Color fundus image · 45-degree field of view: 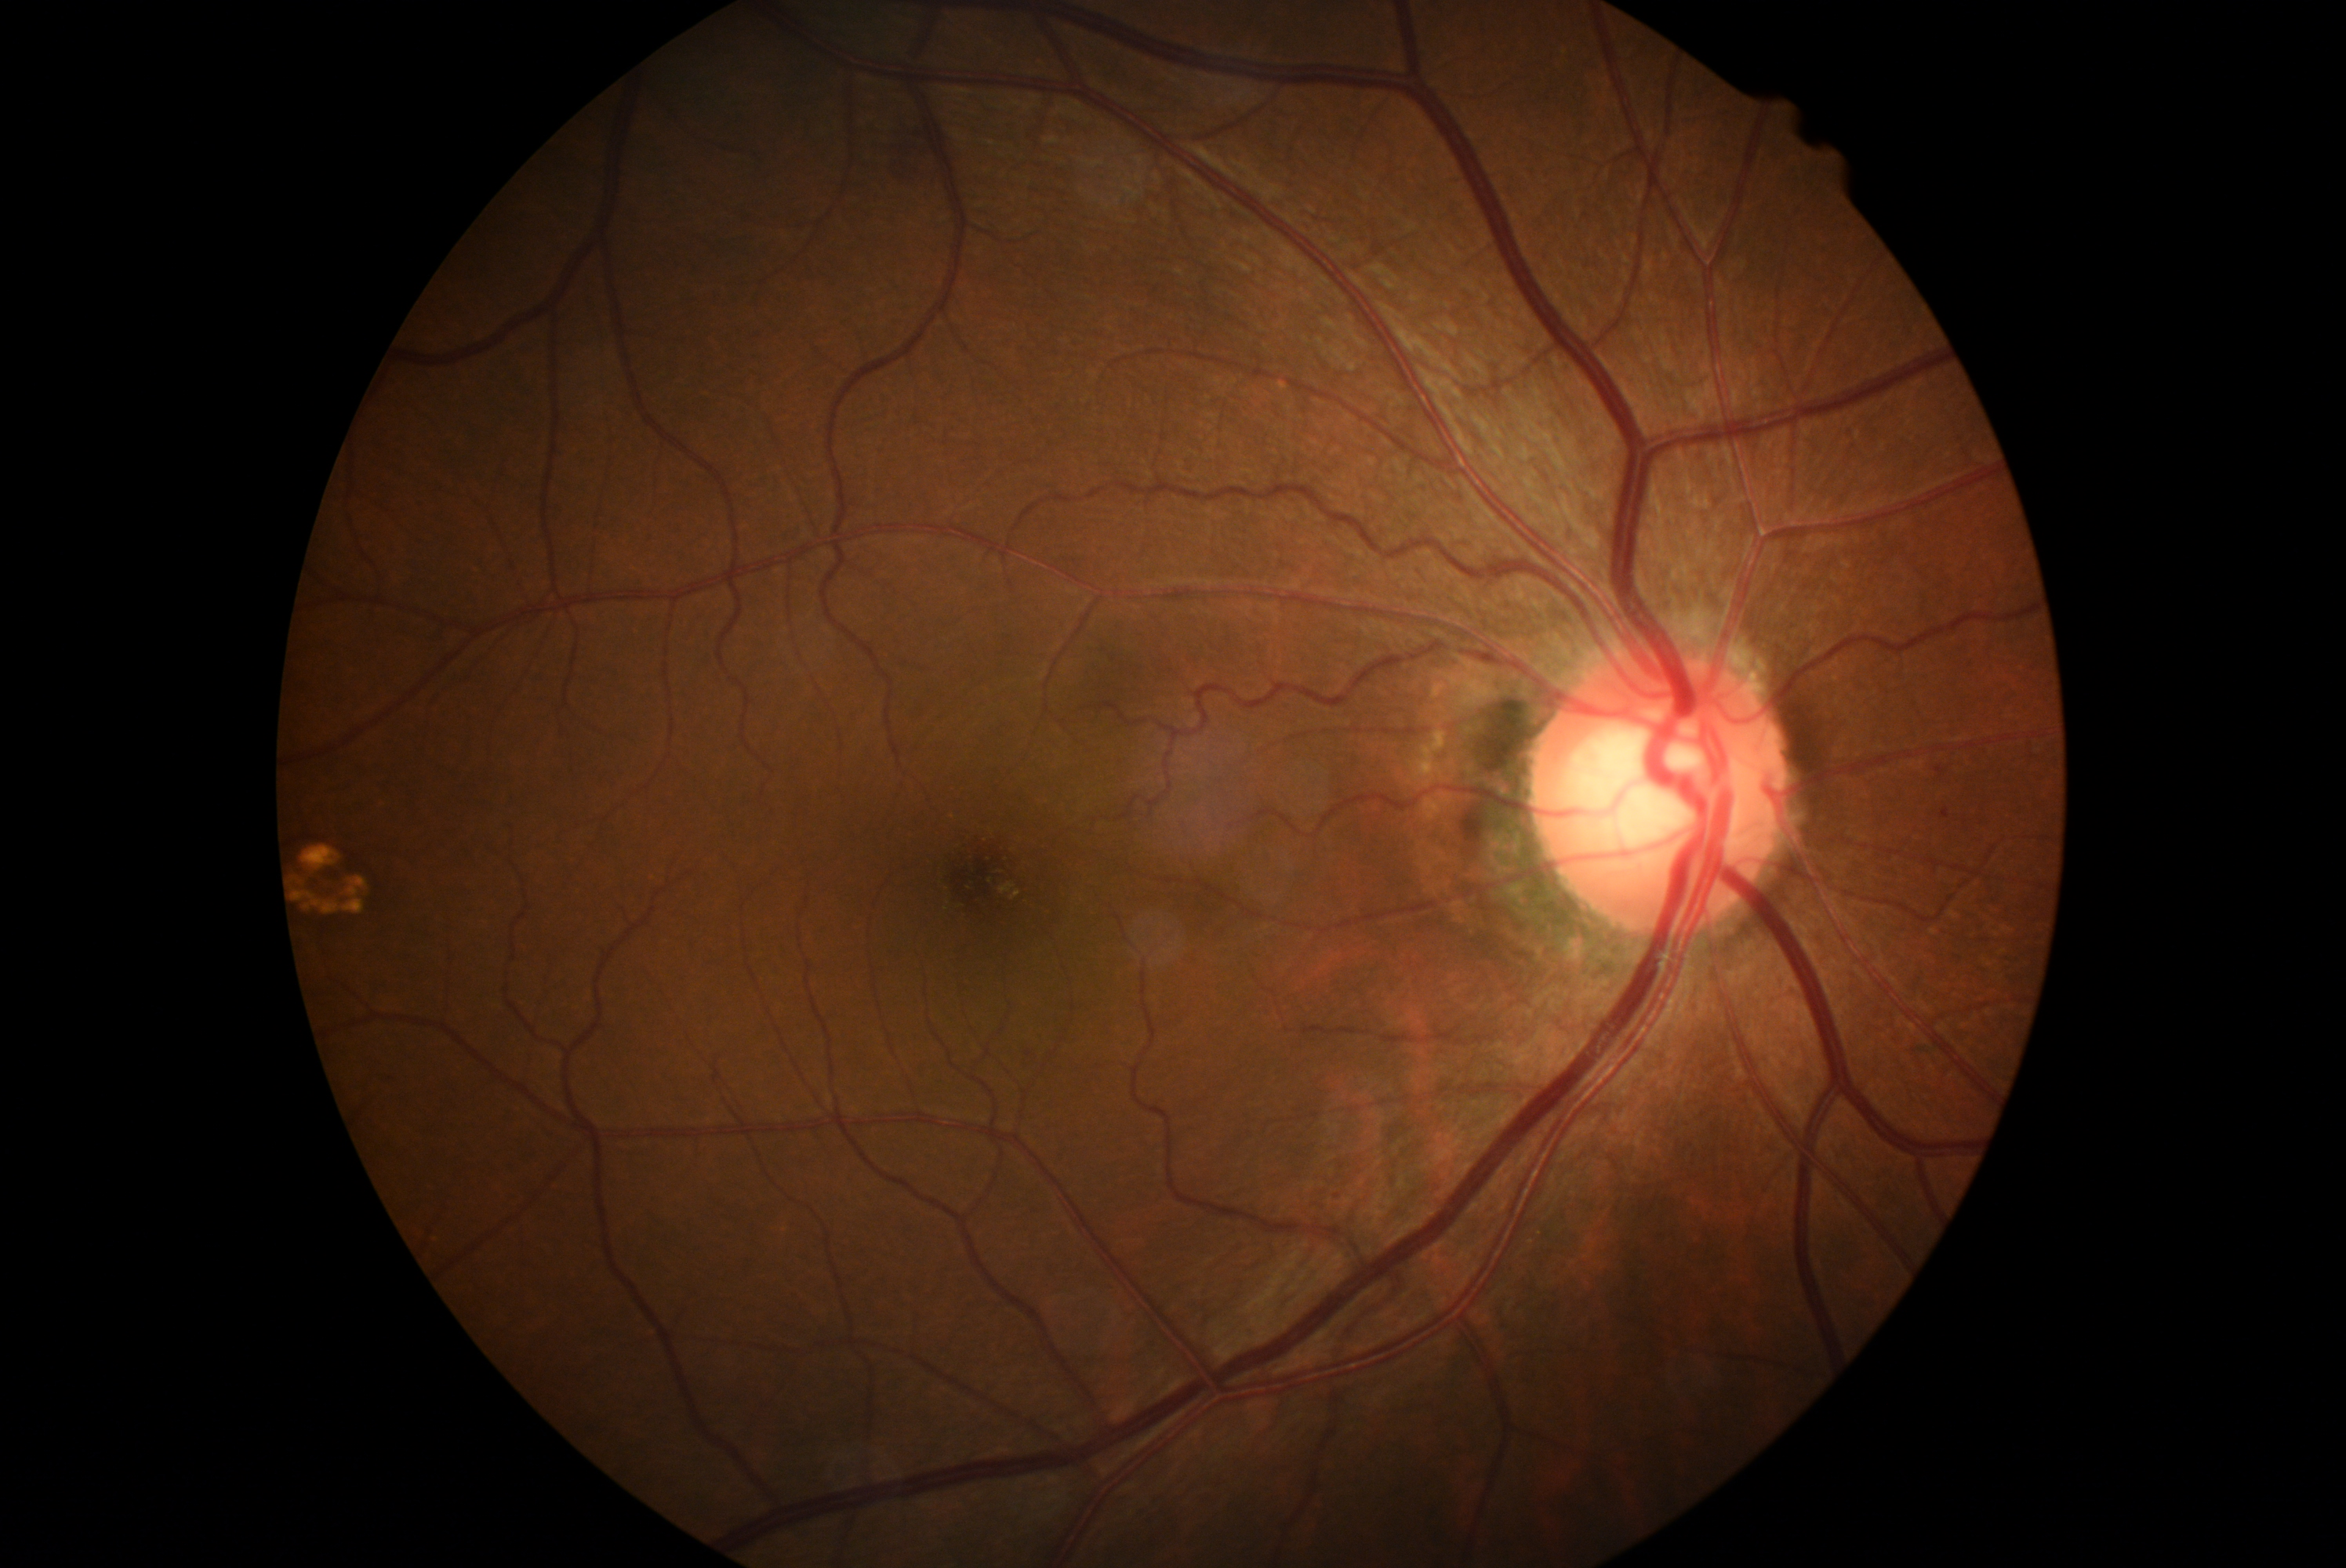
Disease class: non-proliferative diabetic retinopathy. DR: mild non-proliferative diabetic retinopathy (grade 1).